CFP, FOV: 45 degrees.
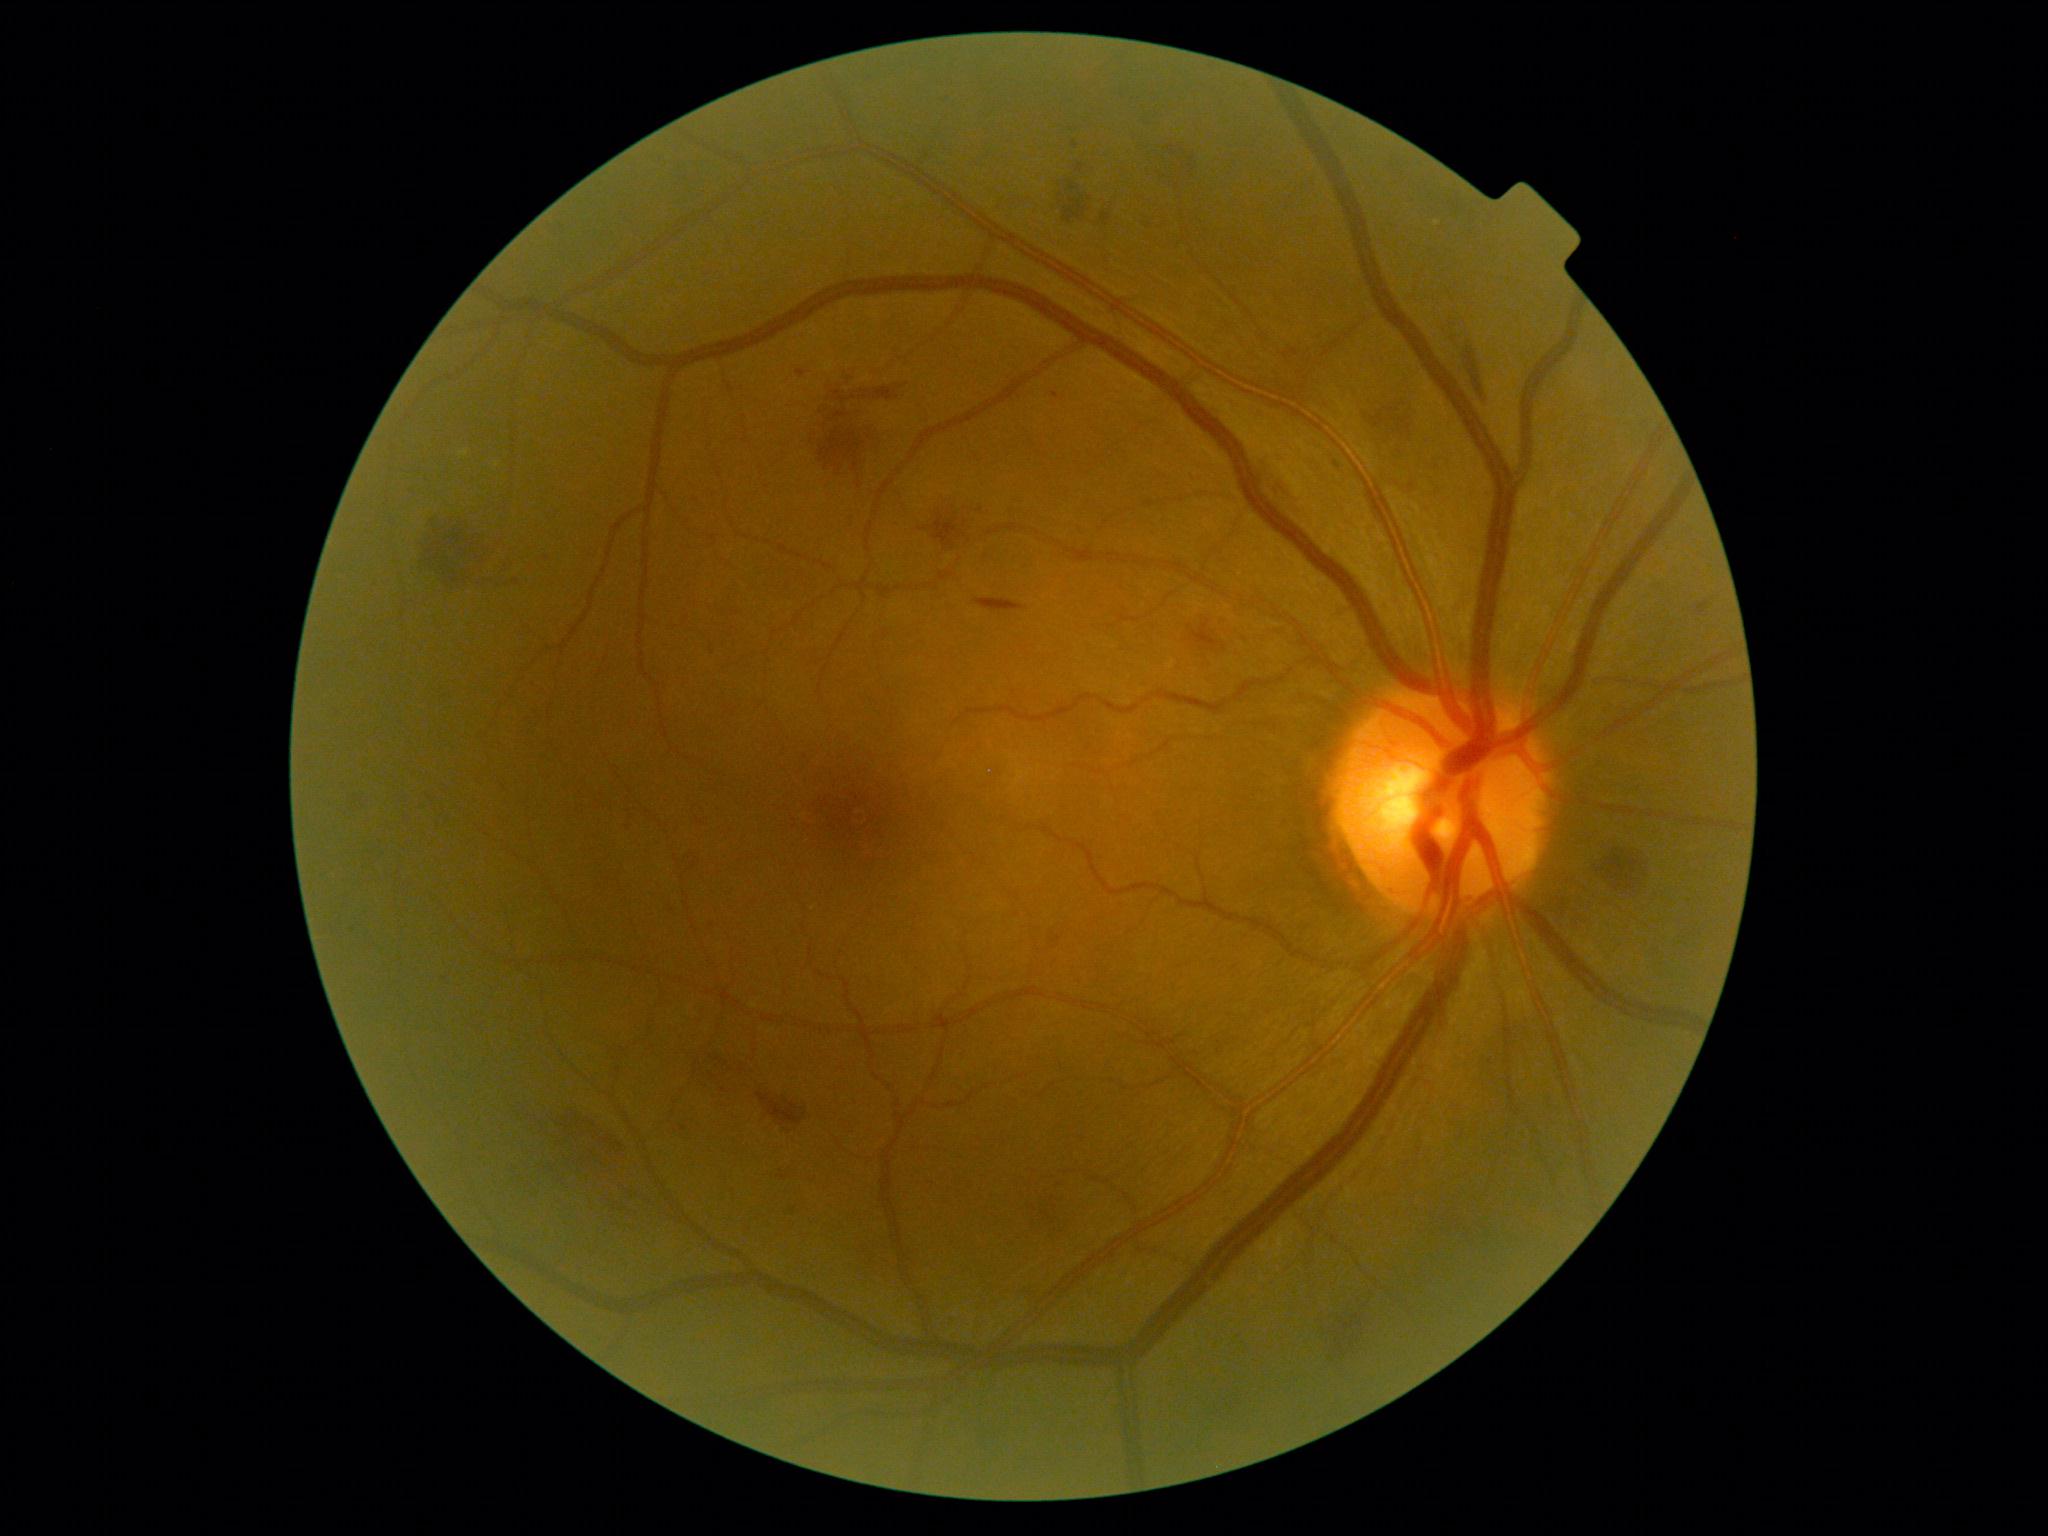 DR severity: grade 2
A subset of detected lesions:
HEs (subset): bbox(757, 1092, 808, 1126); bbox(1069, 182, 1081, 192); bbox(1188, 620, 1227, 653); bbox(1593, 851, 1648, 895); bbox(832, 391, 856, 403); bbox(1063, 199, 1088, 225); bbox(1170, 143, 1197, 183); bbox(790, 1207, 798, 1215); bbox(918, 528, 928, 532); bbox(777, 1169, 790, 1181); bbox(559, 1109, 619, 1158); bbox(859, 383, 909, 401); bbox(1338, 1312, 1362, 1362)